Color fundus photograph · Davis DR grading · 848 by 848 pixels:
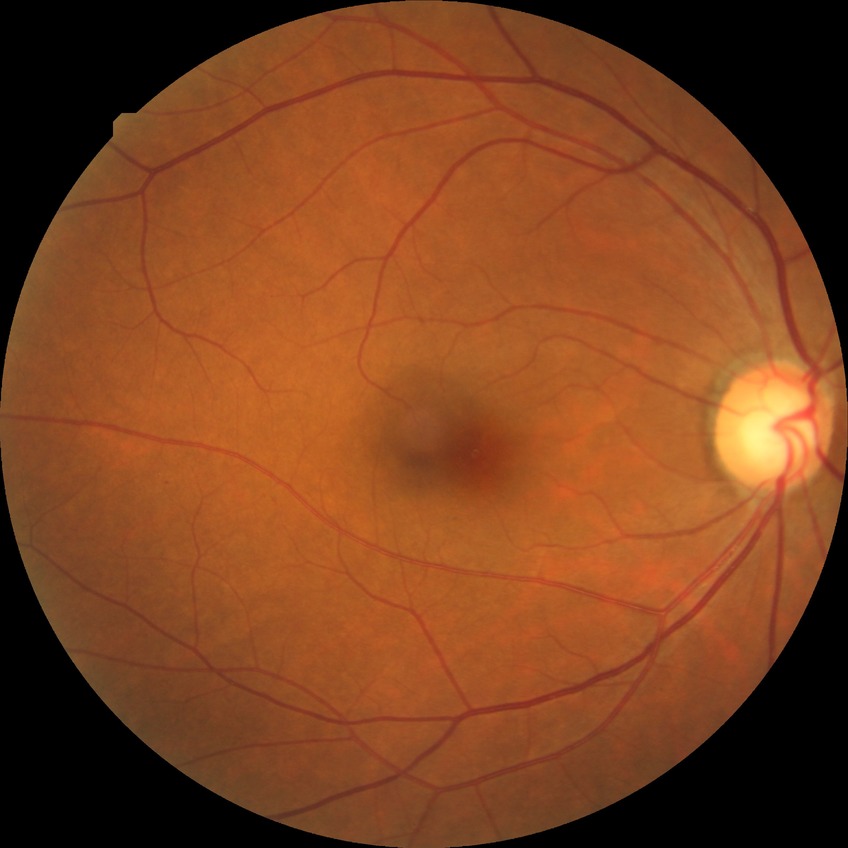 Diabetic retinopathy (DR) is NDR (no diabetic retinopathy).